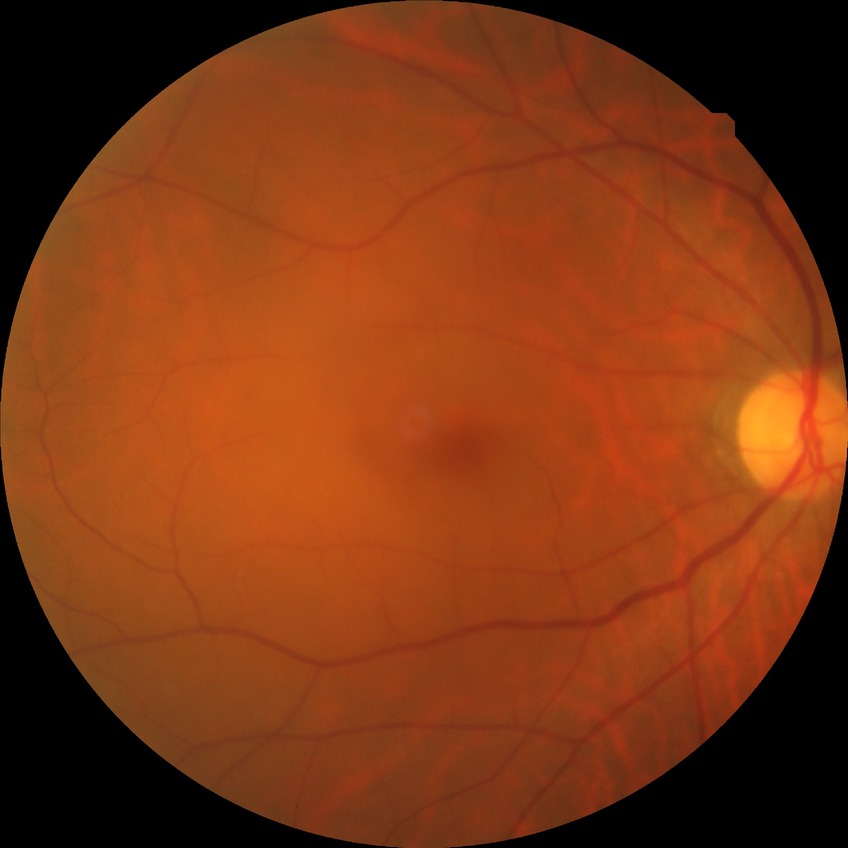 Diabetic retinopathy (DR): no diabetic retinopathy (NDR).